Portable fundus camera image:
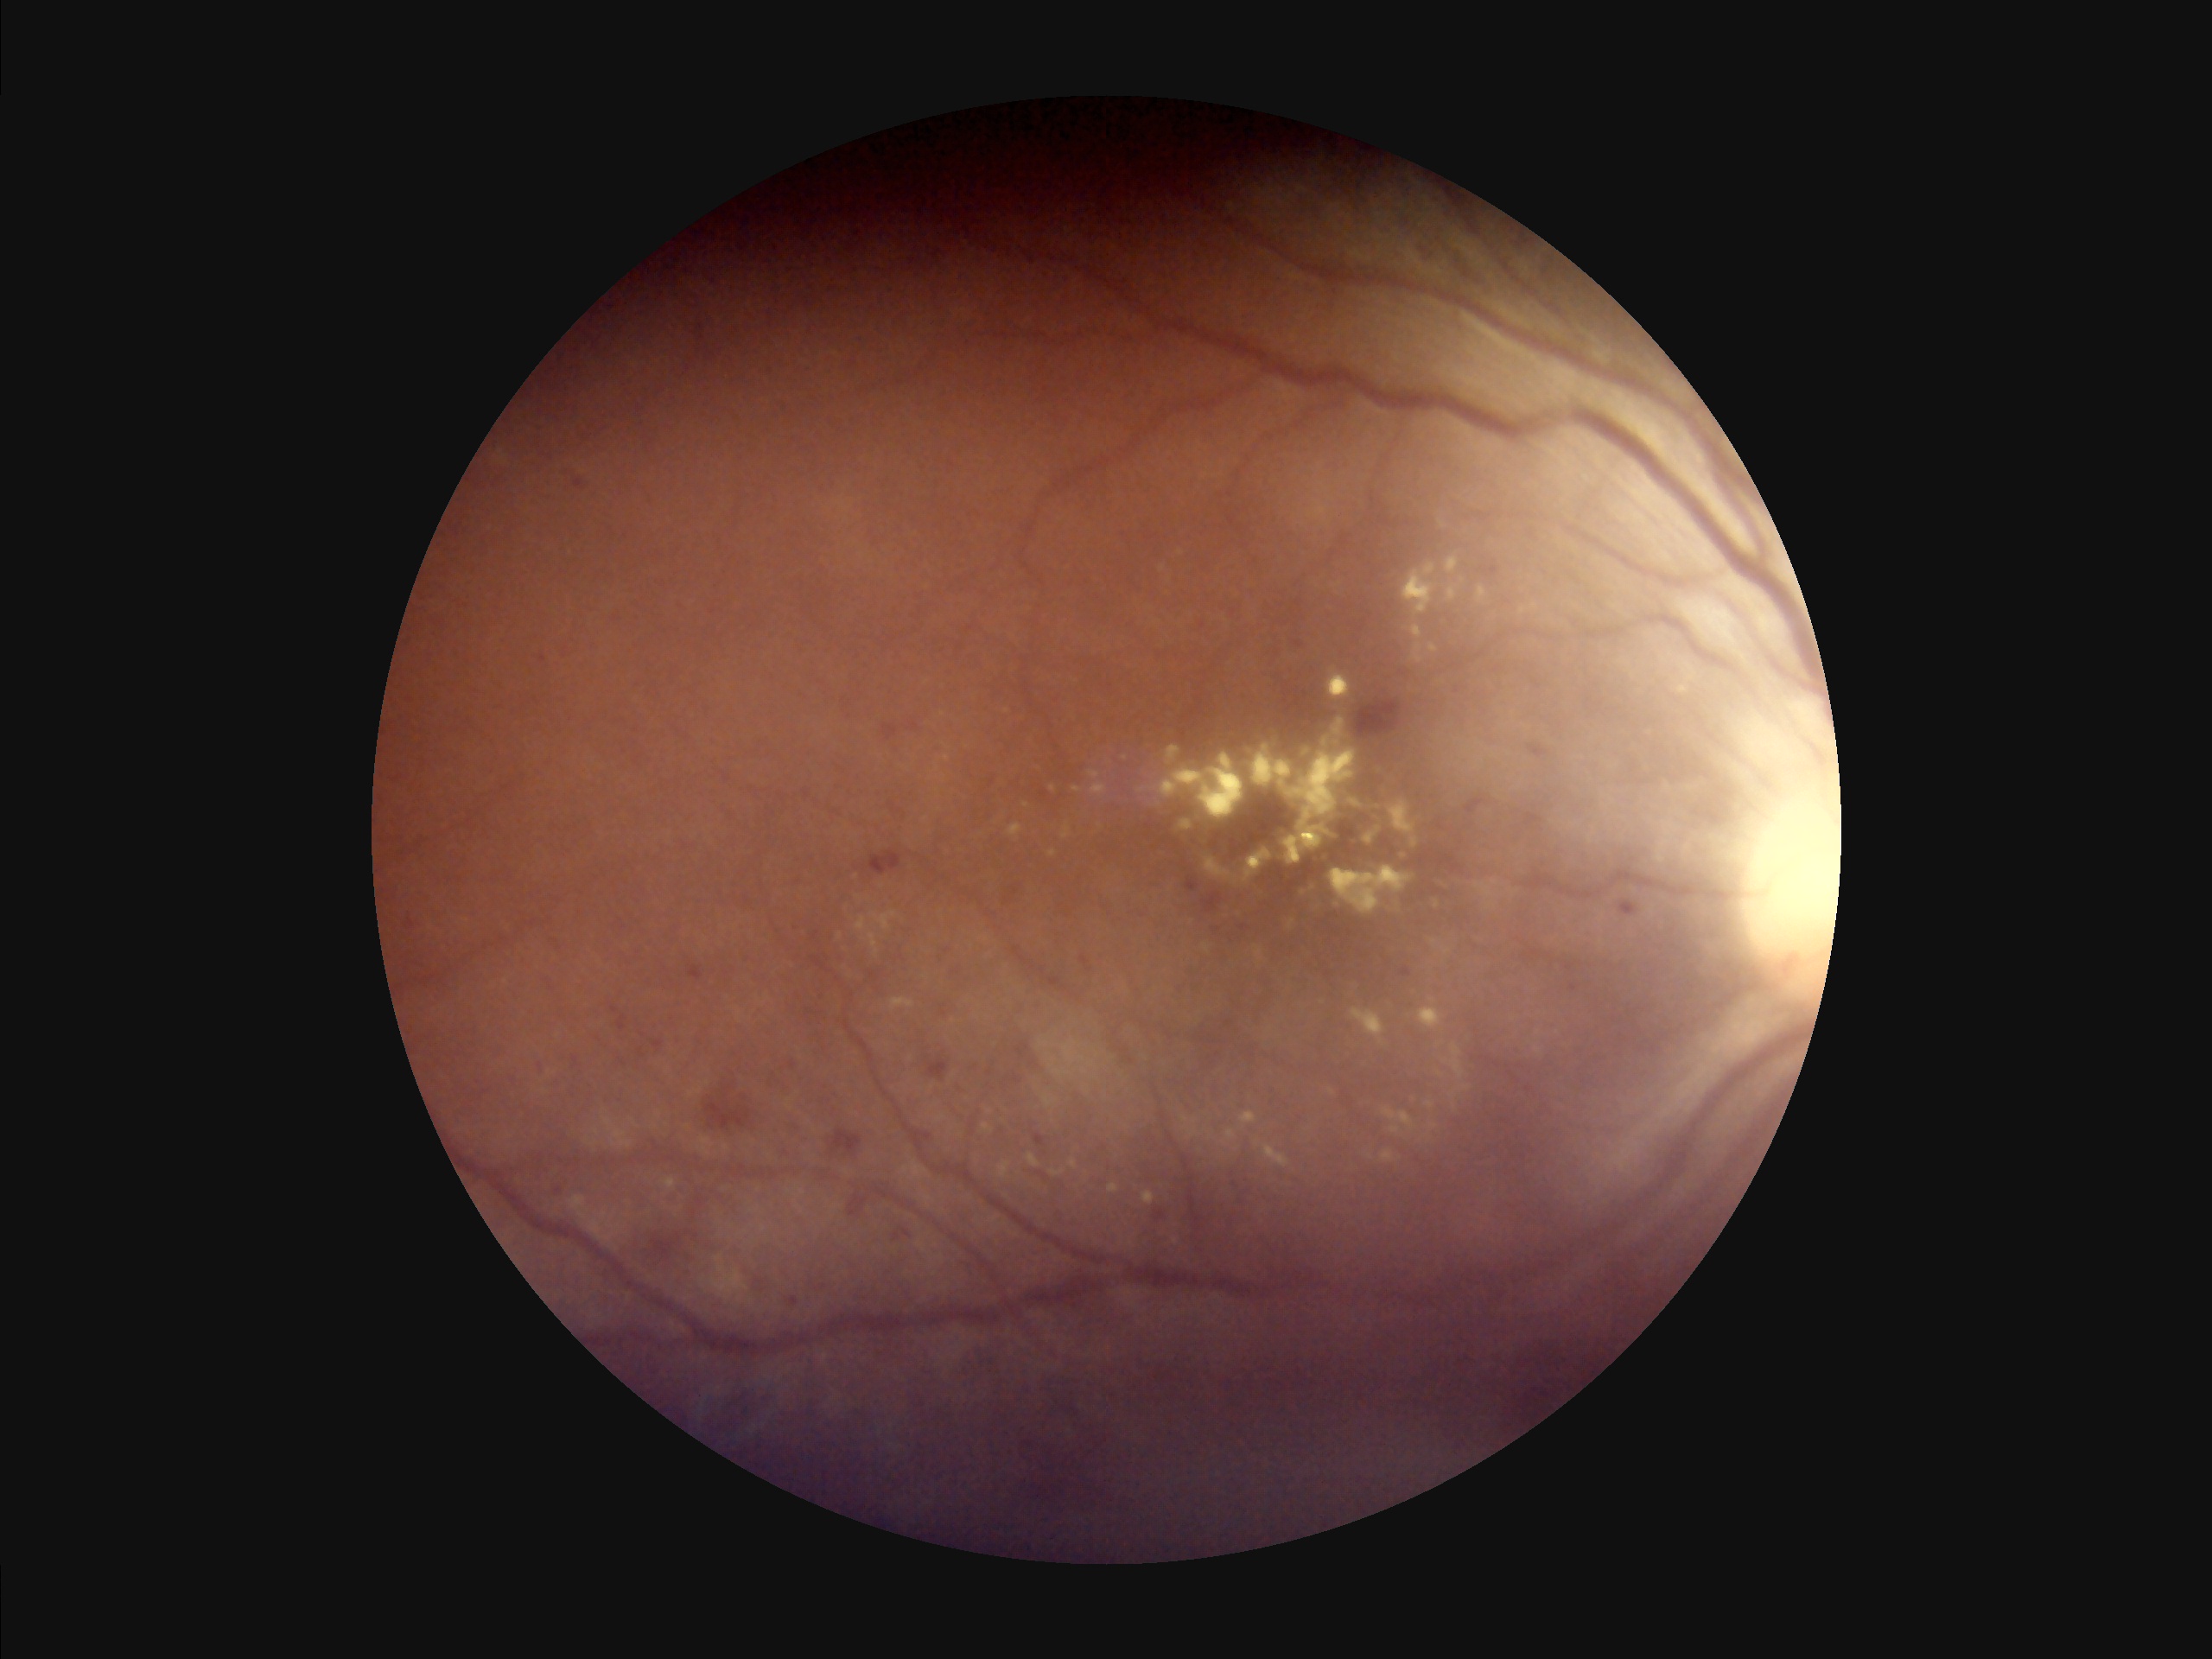

Image quality assessment:
- contrast: poor dynamic range
- overall: inadequate for clinical interpretation
- illumination: inadequate, with uneven exposure or color distortion
- clarity: optic disc, vessels, and background in focus